Wide-field retinal mosaic image:
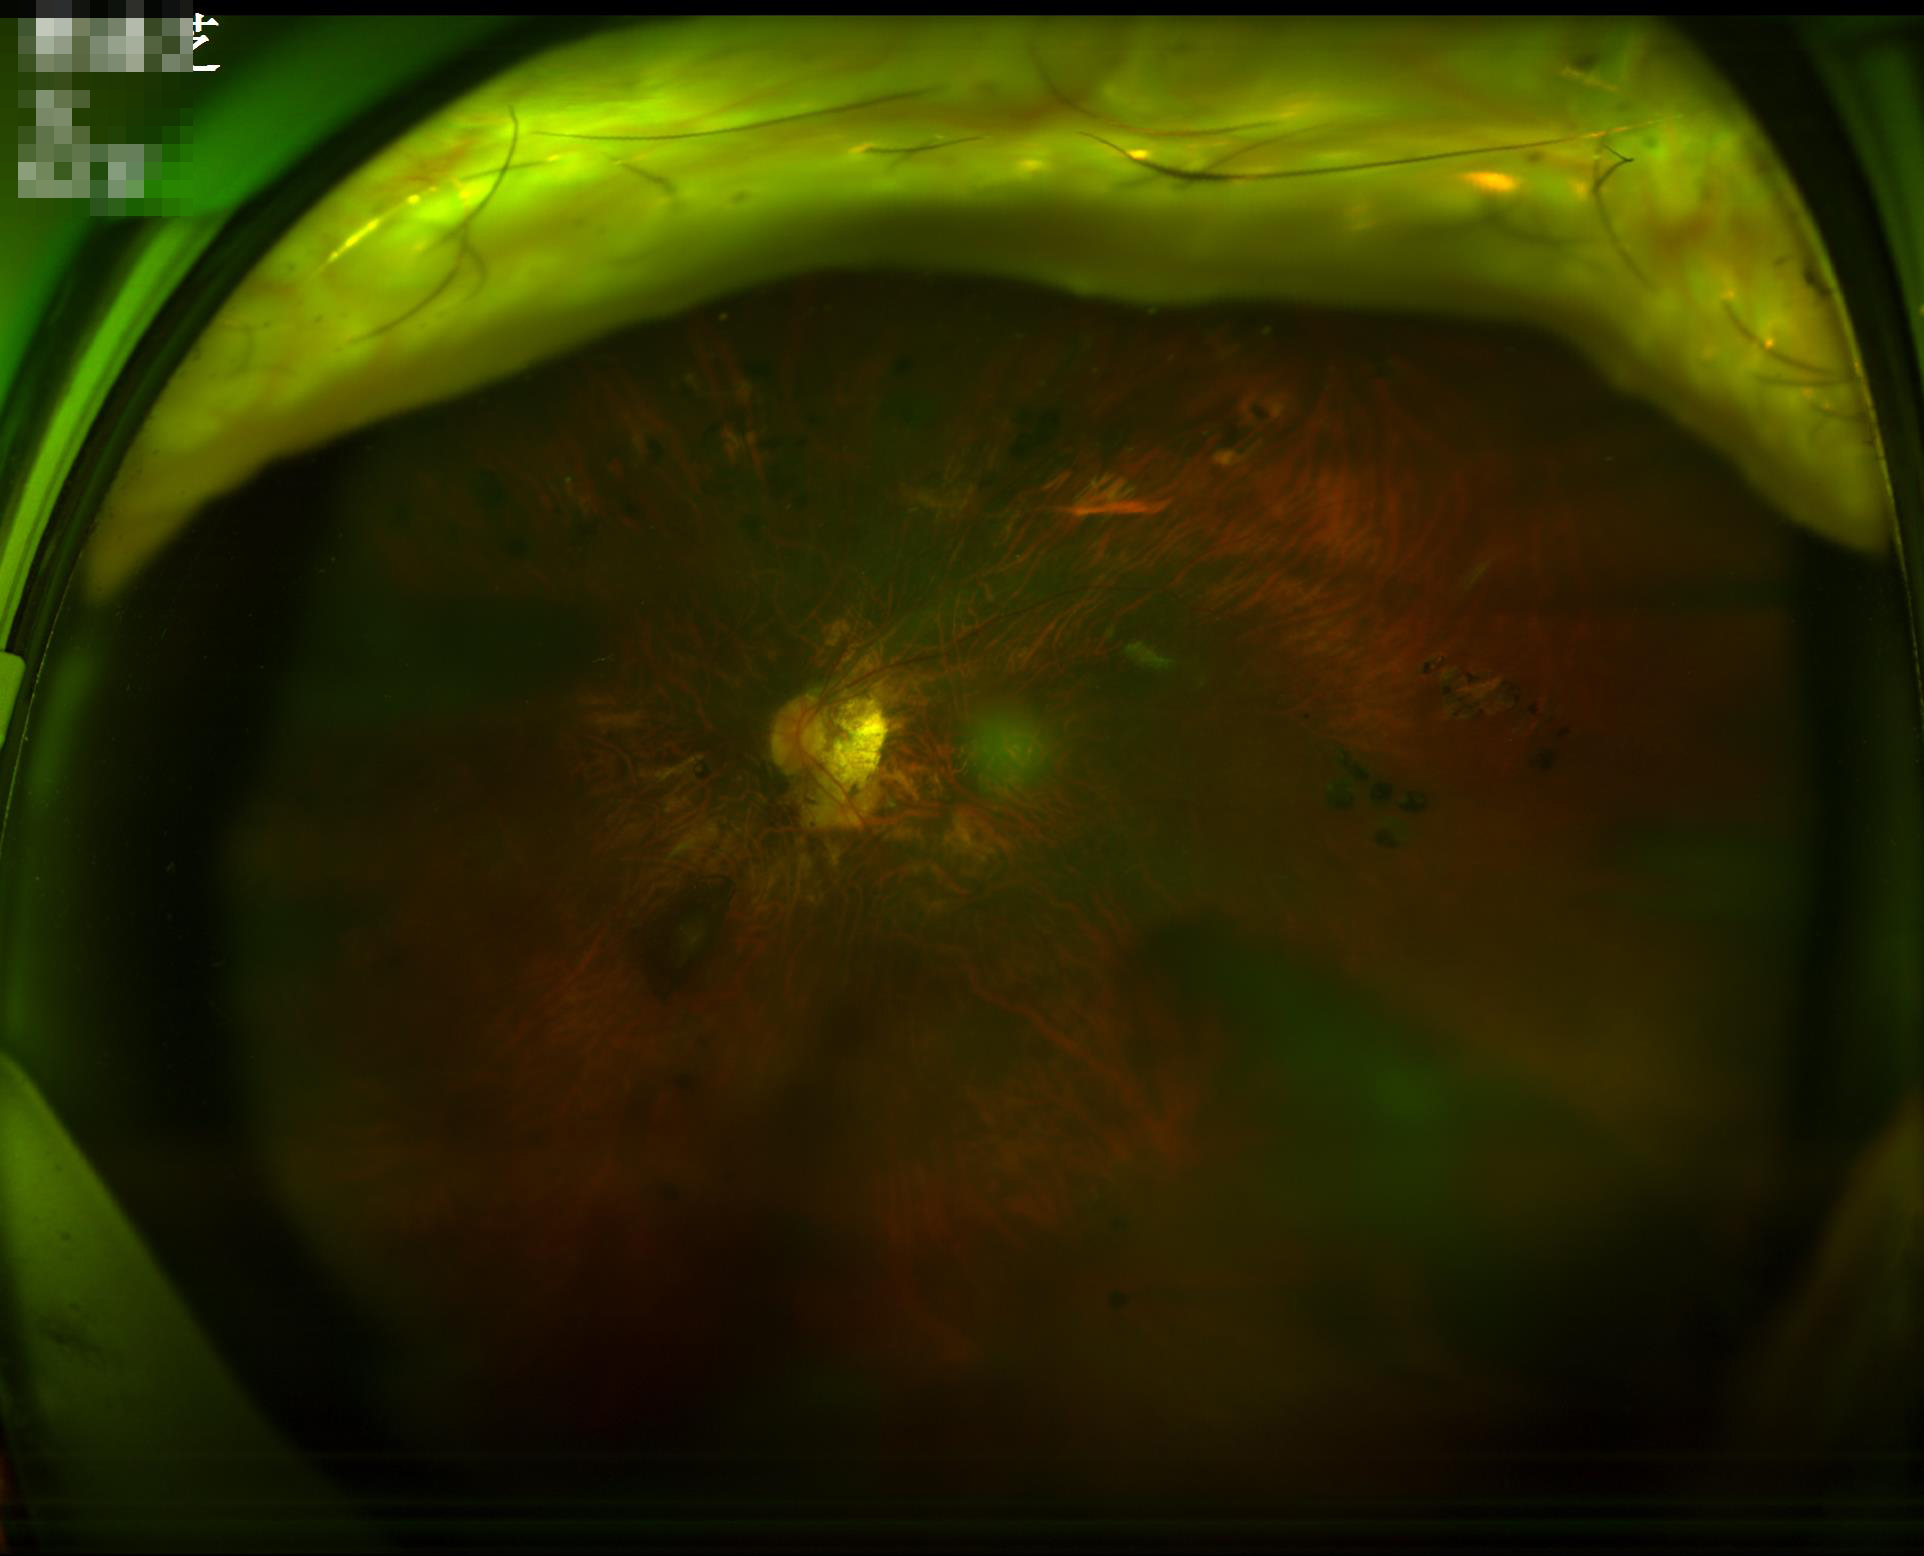 There is over- or under-exposure or a color cast. The image is blurry. Narrow intensity range; structures are hard to distinguish. Overall image quality is poor.